Non-mydriatic acquisition: 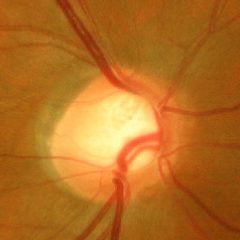

Assessment = advanced glaucomatous optic neuropathy.